50° field of view · Topcon TRC-50DX · pupil-dilated:
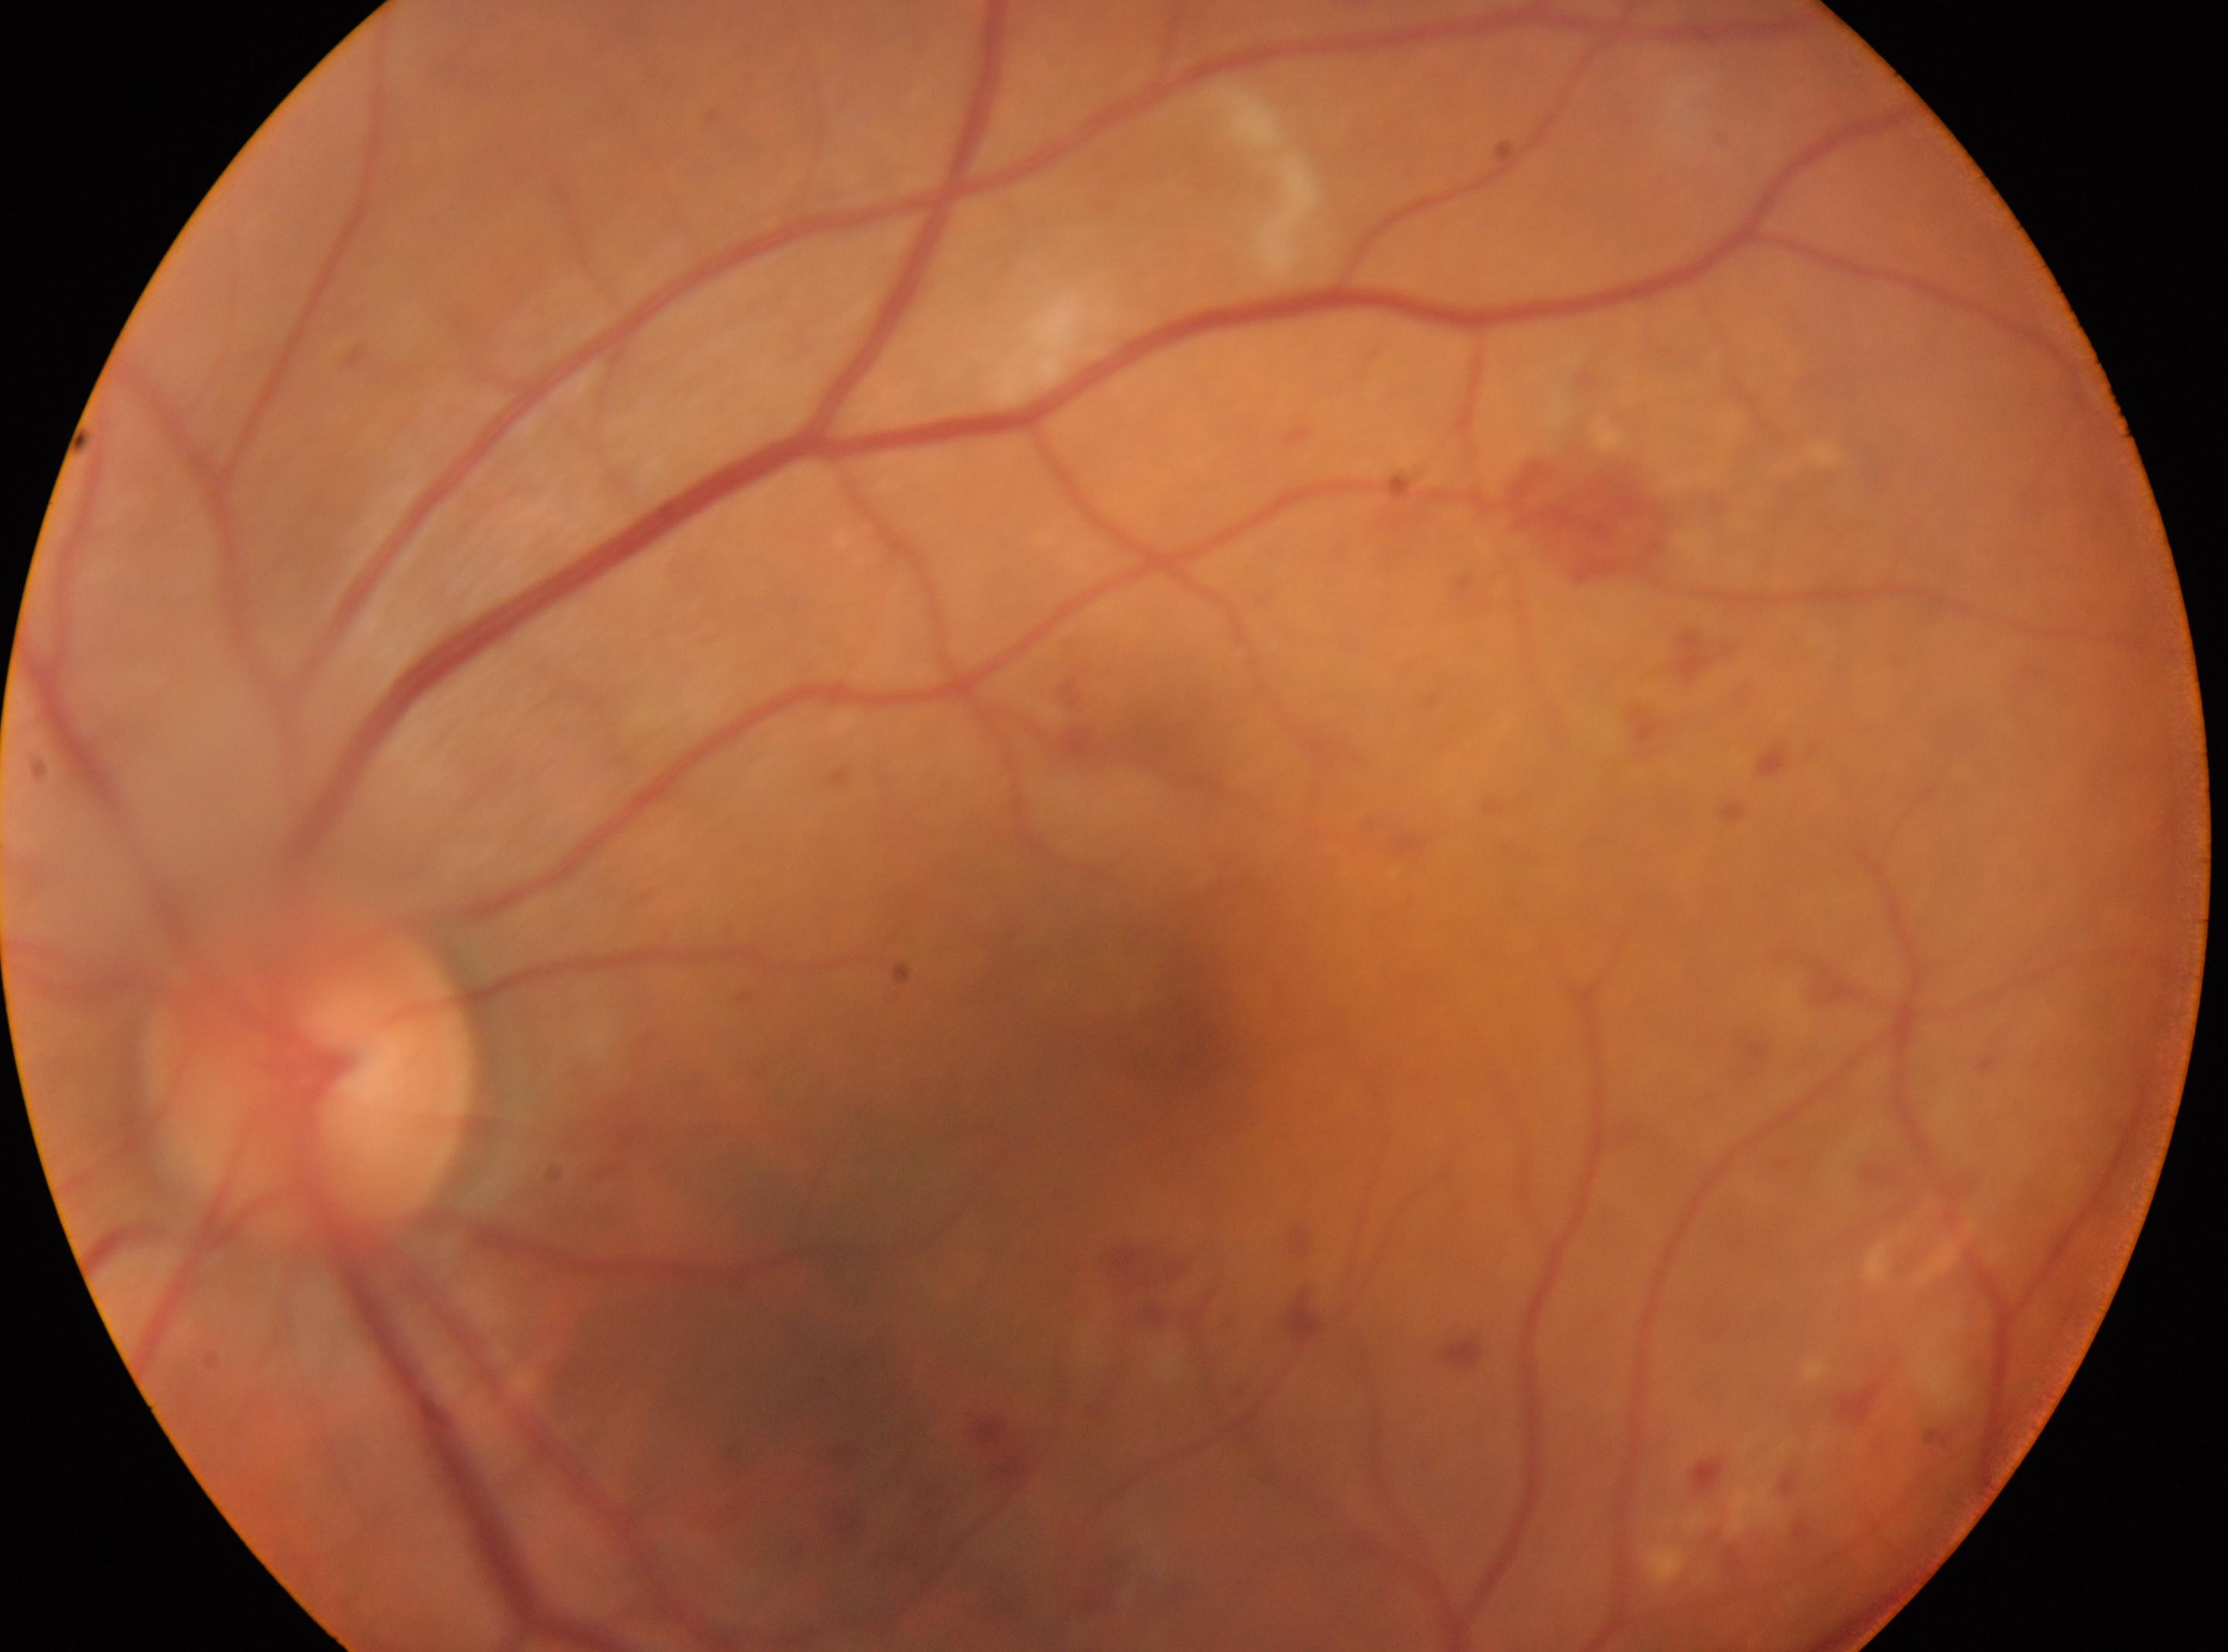
Q: Locate the fovea.
A: (1171, 1046)
Q: What is the laterality?
A: OS
Q: Locate the optic disc.
A: (307, 1073)
Q: What disease class is present?
A: non-proliferative diabetic retinopathy
Q: DR stage?
A: 2 (moderate NPDR)